Captured on a Topcon TRC-50DX fundus camera, retinal fundus photograph, central posterior field
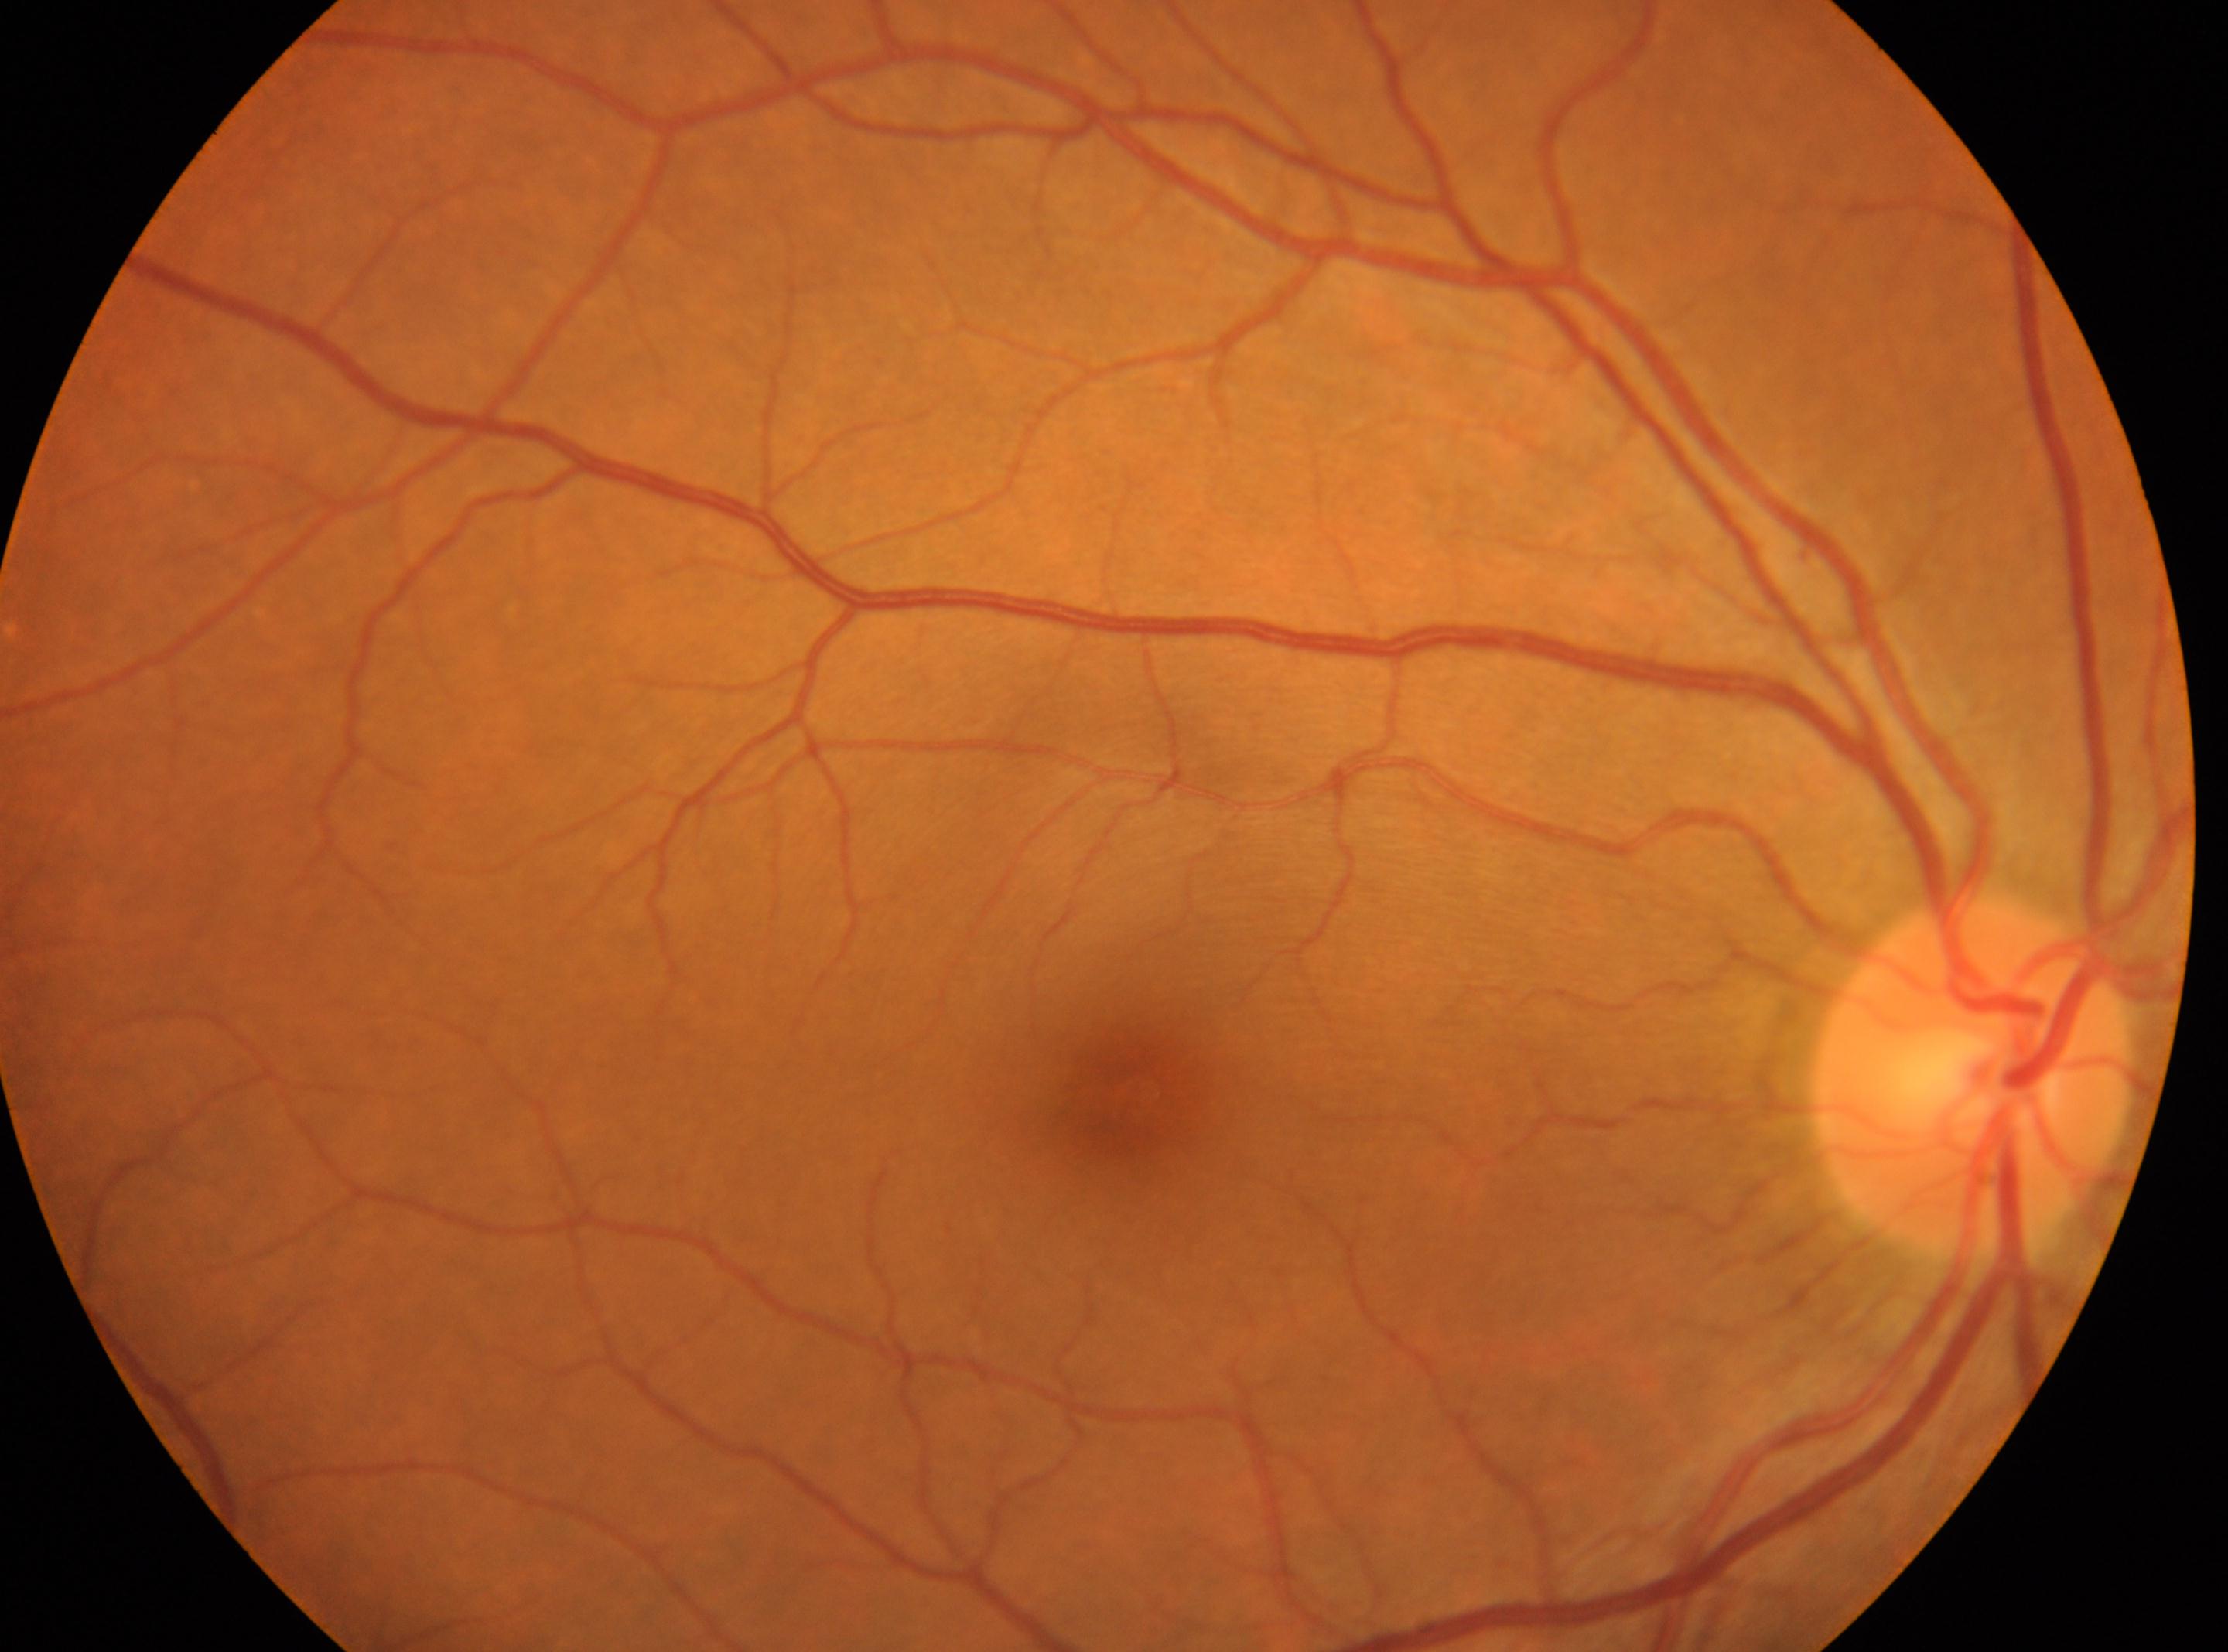
Findings:
• ONH: (1972, 1079)
• foveal center: (1137, 1091)
• DR severity: grade 0
• DR impression: No apparent diabetic retinopathy
• laterality: right